240 x 240 pixels. Optic nerve head crop. Non-mydriatic acquisition — 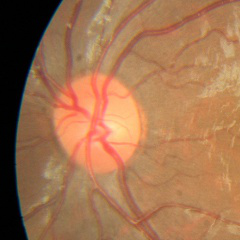
Q: What is the glaucoma diagnosis?
A: No — no glaucomatous changes.